Wide-field fundus image from infant ROP screening. Camera: Clarity RetCam 3 (130° FOV) — 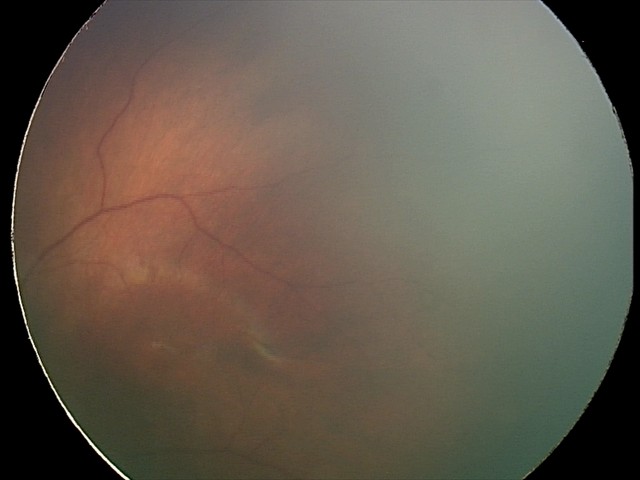 Impression: normal fundus examination.